Color fundus image, 45° FOV:
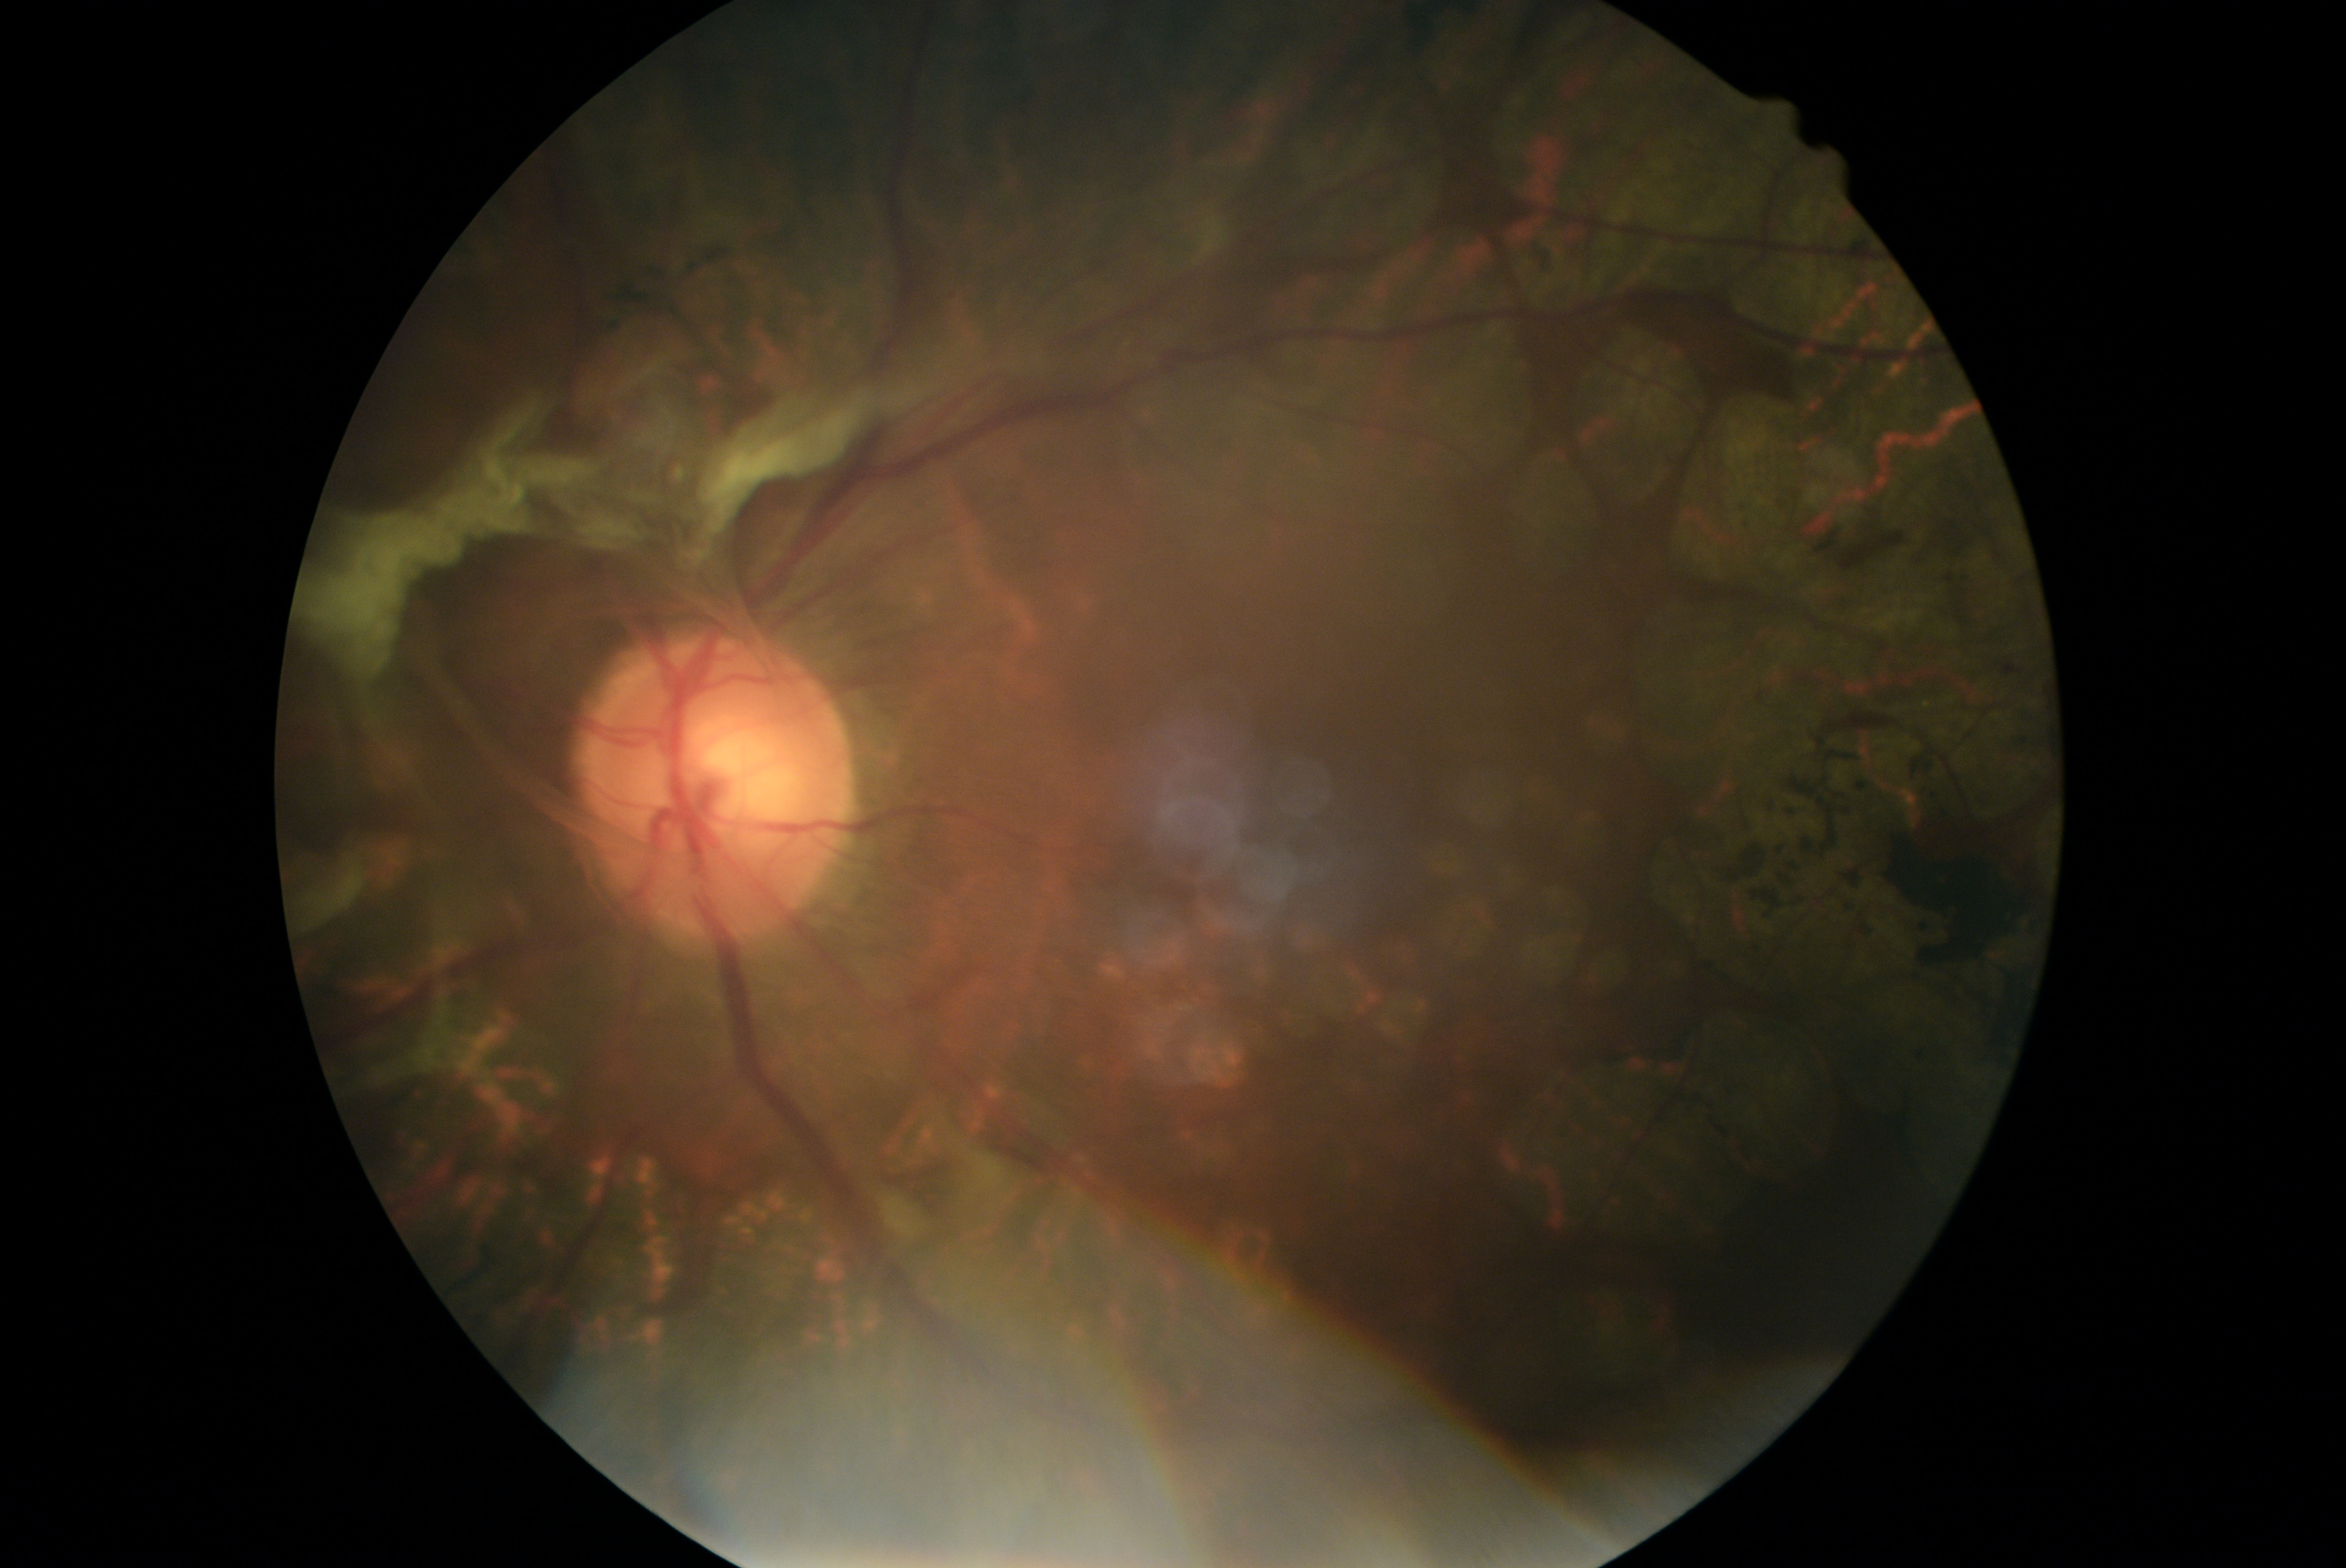

diabetic retinopathy (DR)=4; DR class=proliferative diabetic retinopathy.